Captured on a Nidek AFC-330 fundus camera — 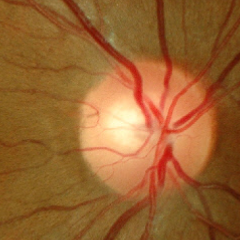
Q: What stage of glaucoma is present?
A: No glaucoma.